FOV: 45 degrees: 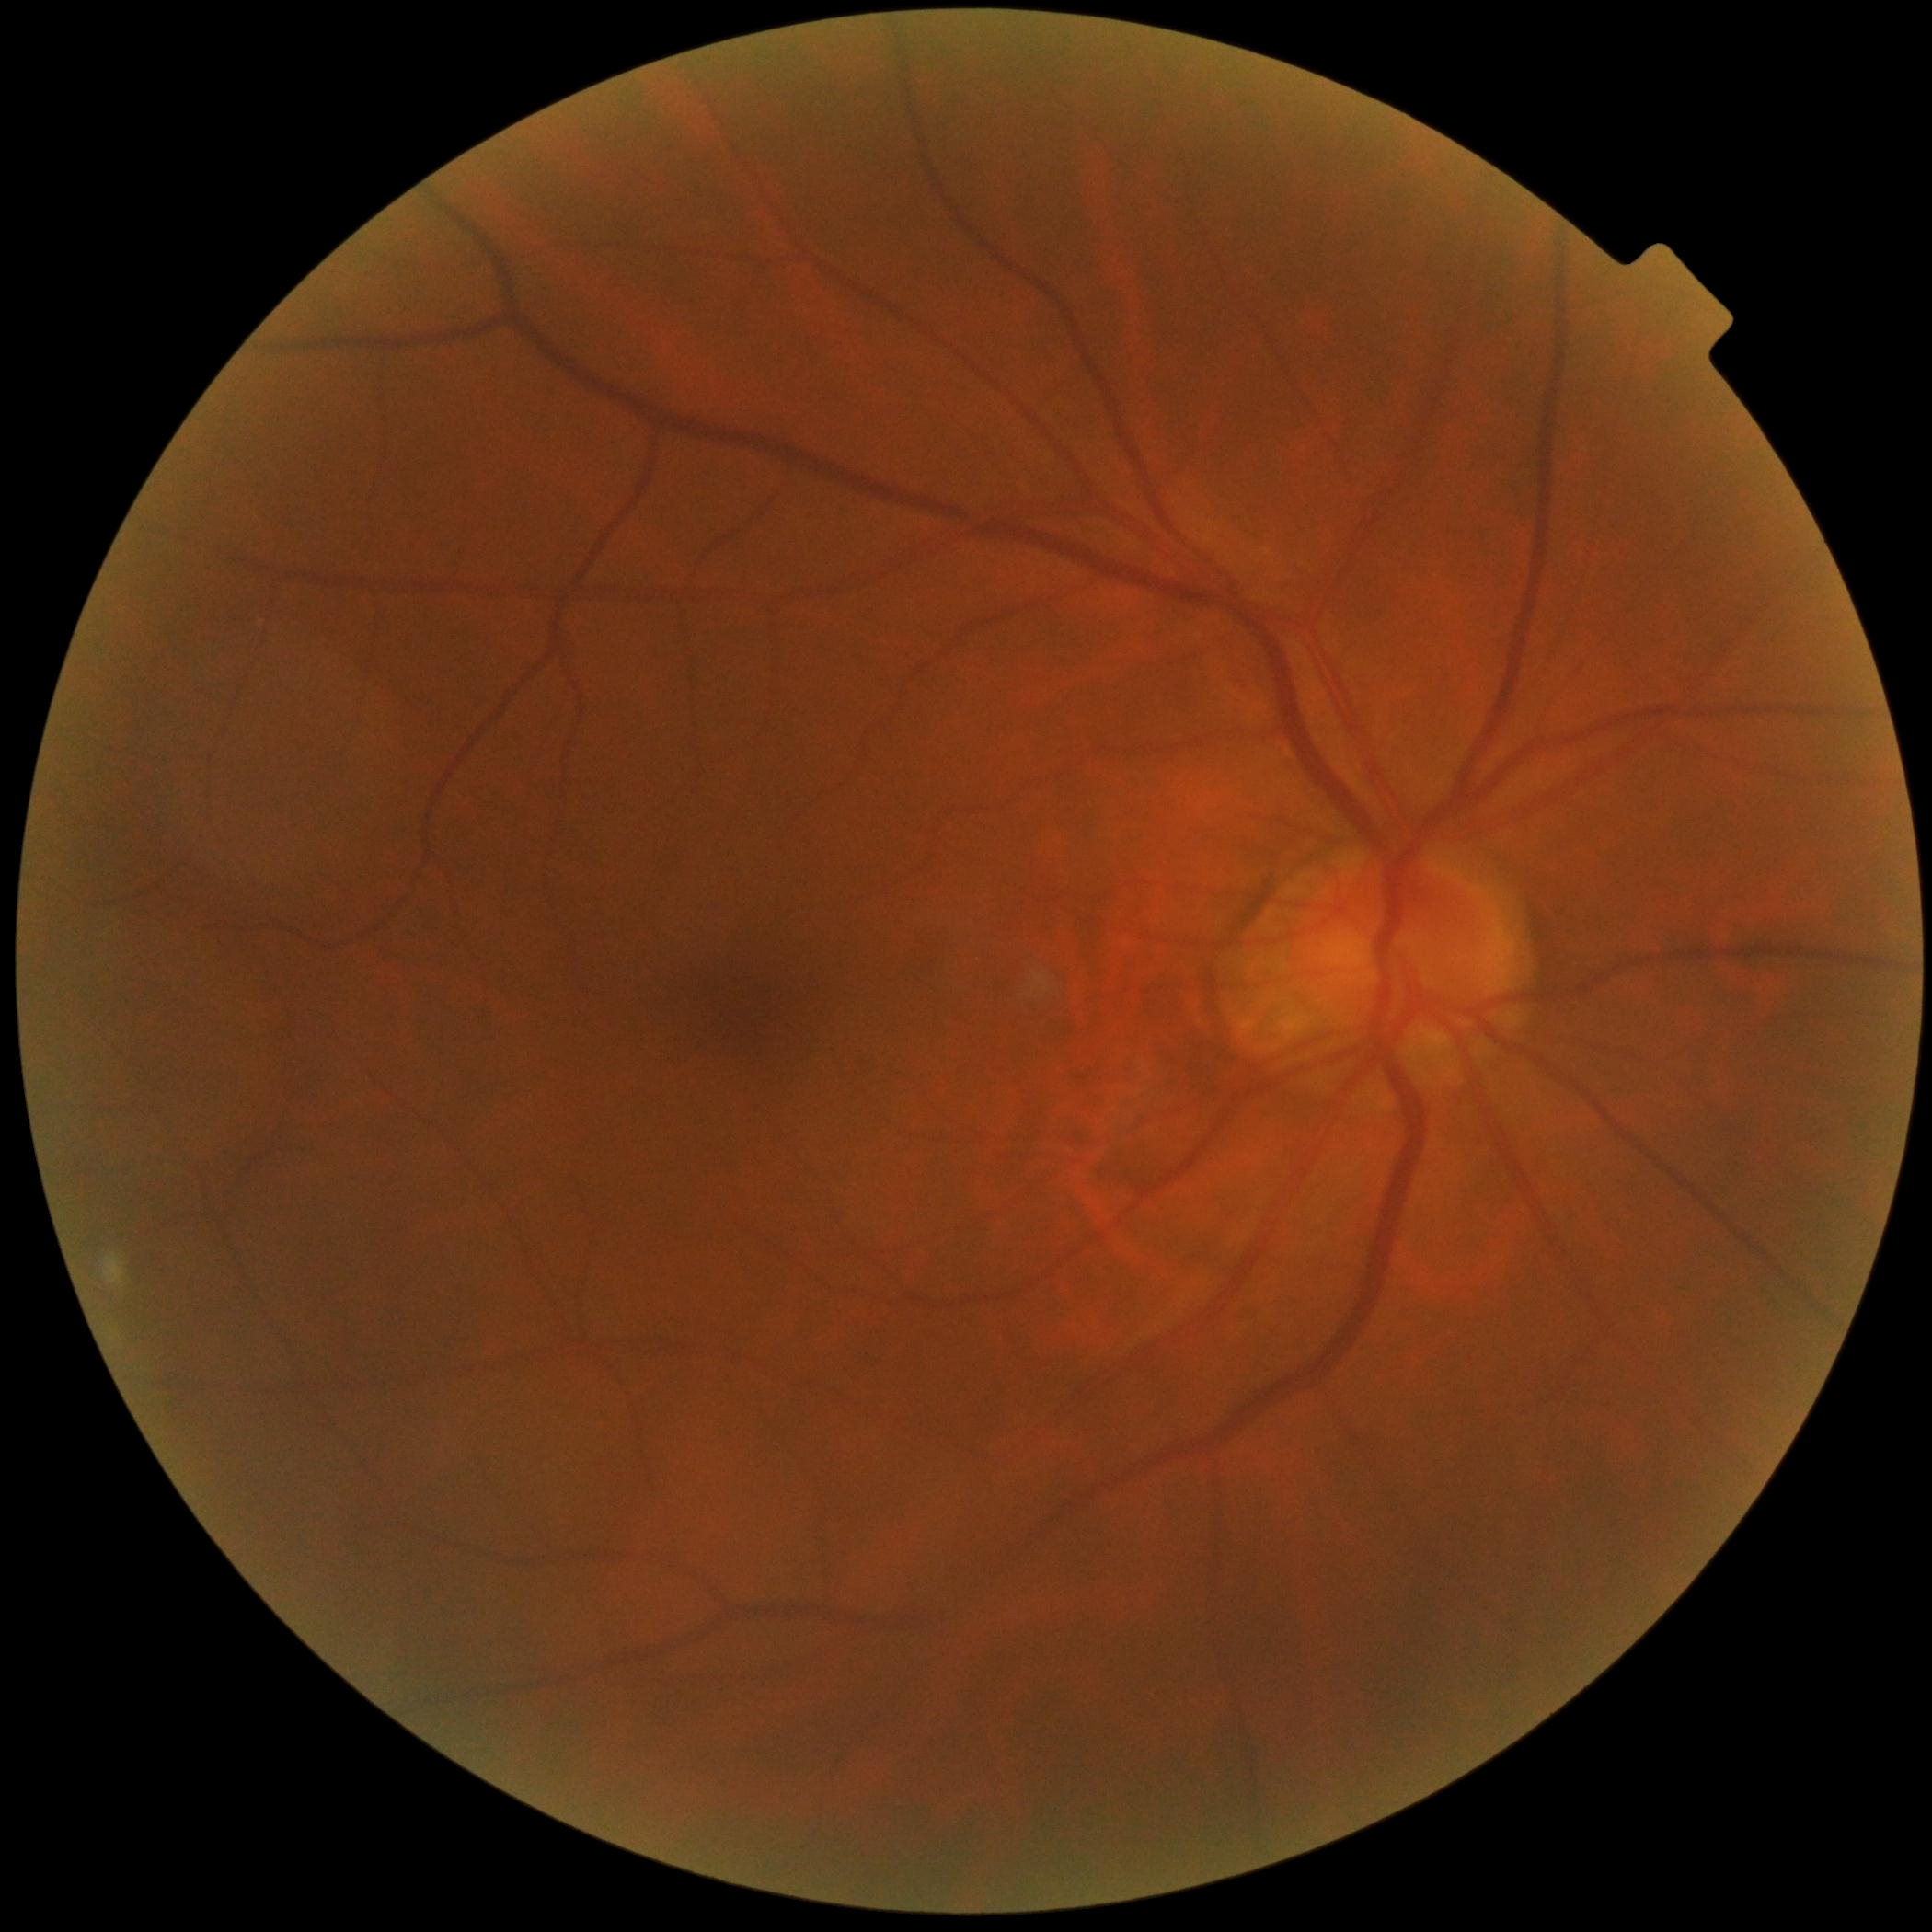

Retinopathy grade is 0.